848x848 — 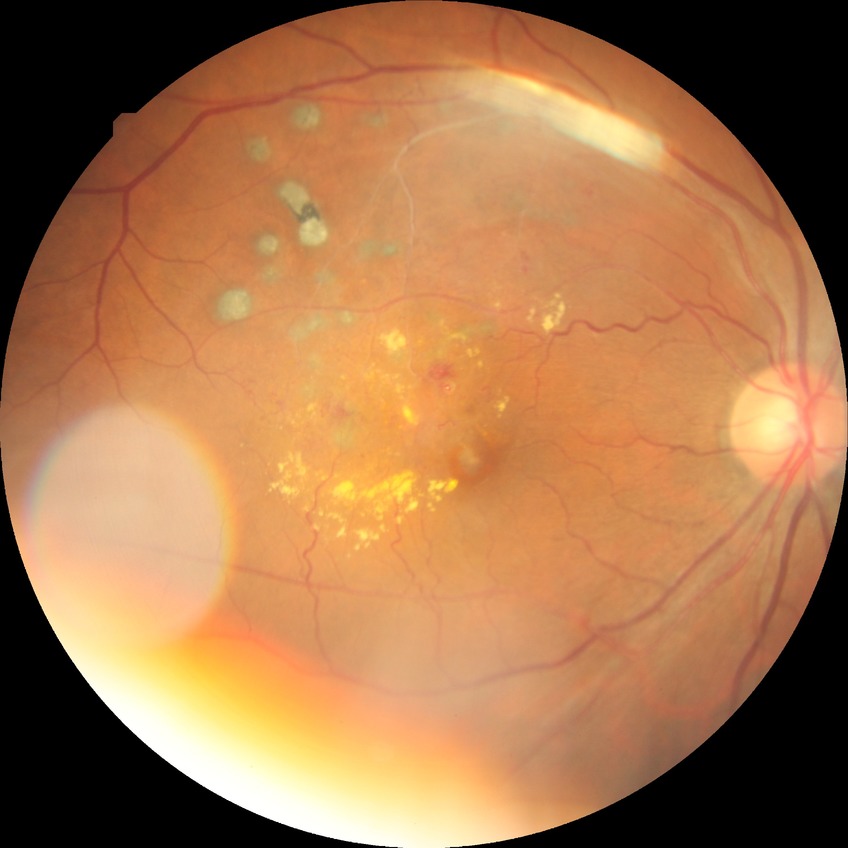 * DR impression: no apparent DR
* modified Davis grade: NDR